Captured on a Nidek AFC-330 fundus camera. Optic disc region crop
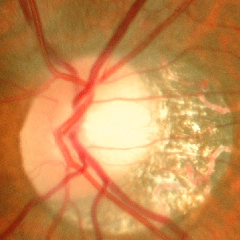

Optic nerve head appearance consistent with no glaucomatous changes.